FOV: 45 degrees. 848 by 848 pixels: 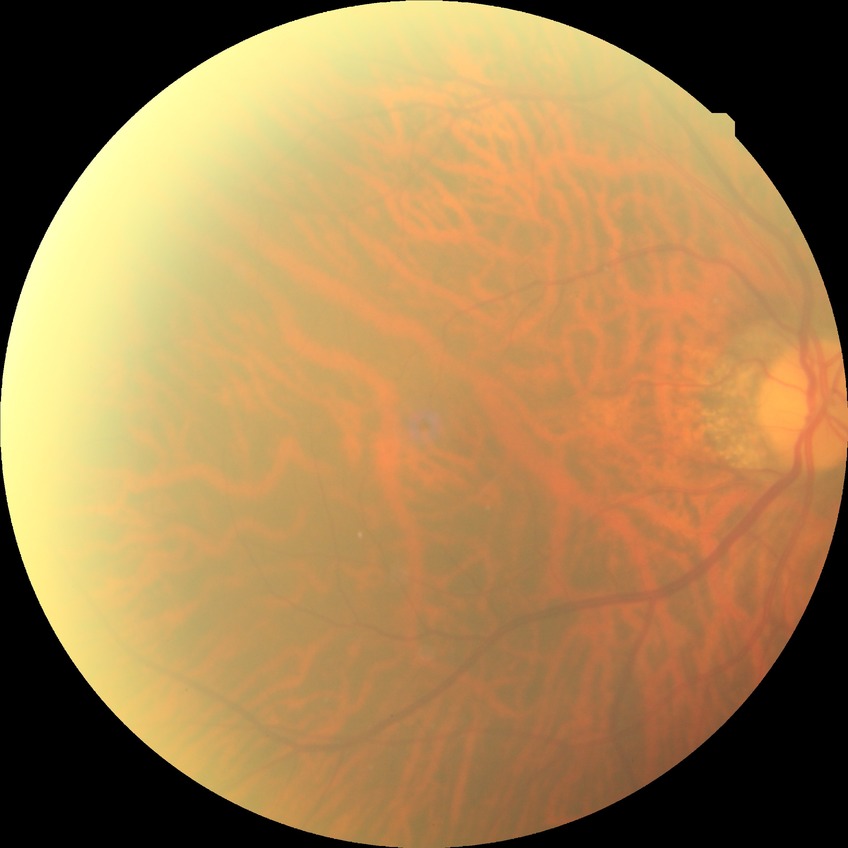
Davis DR grade: NDR | DR impression: no apparent DR.